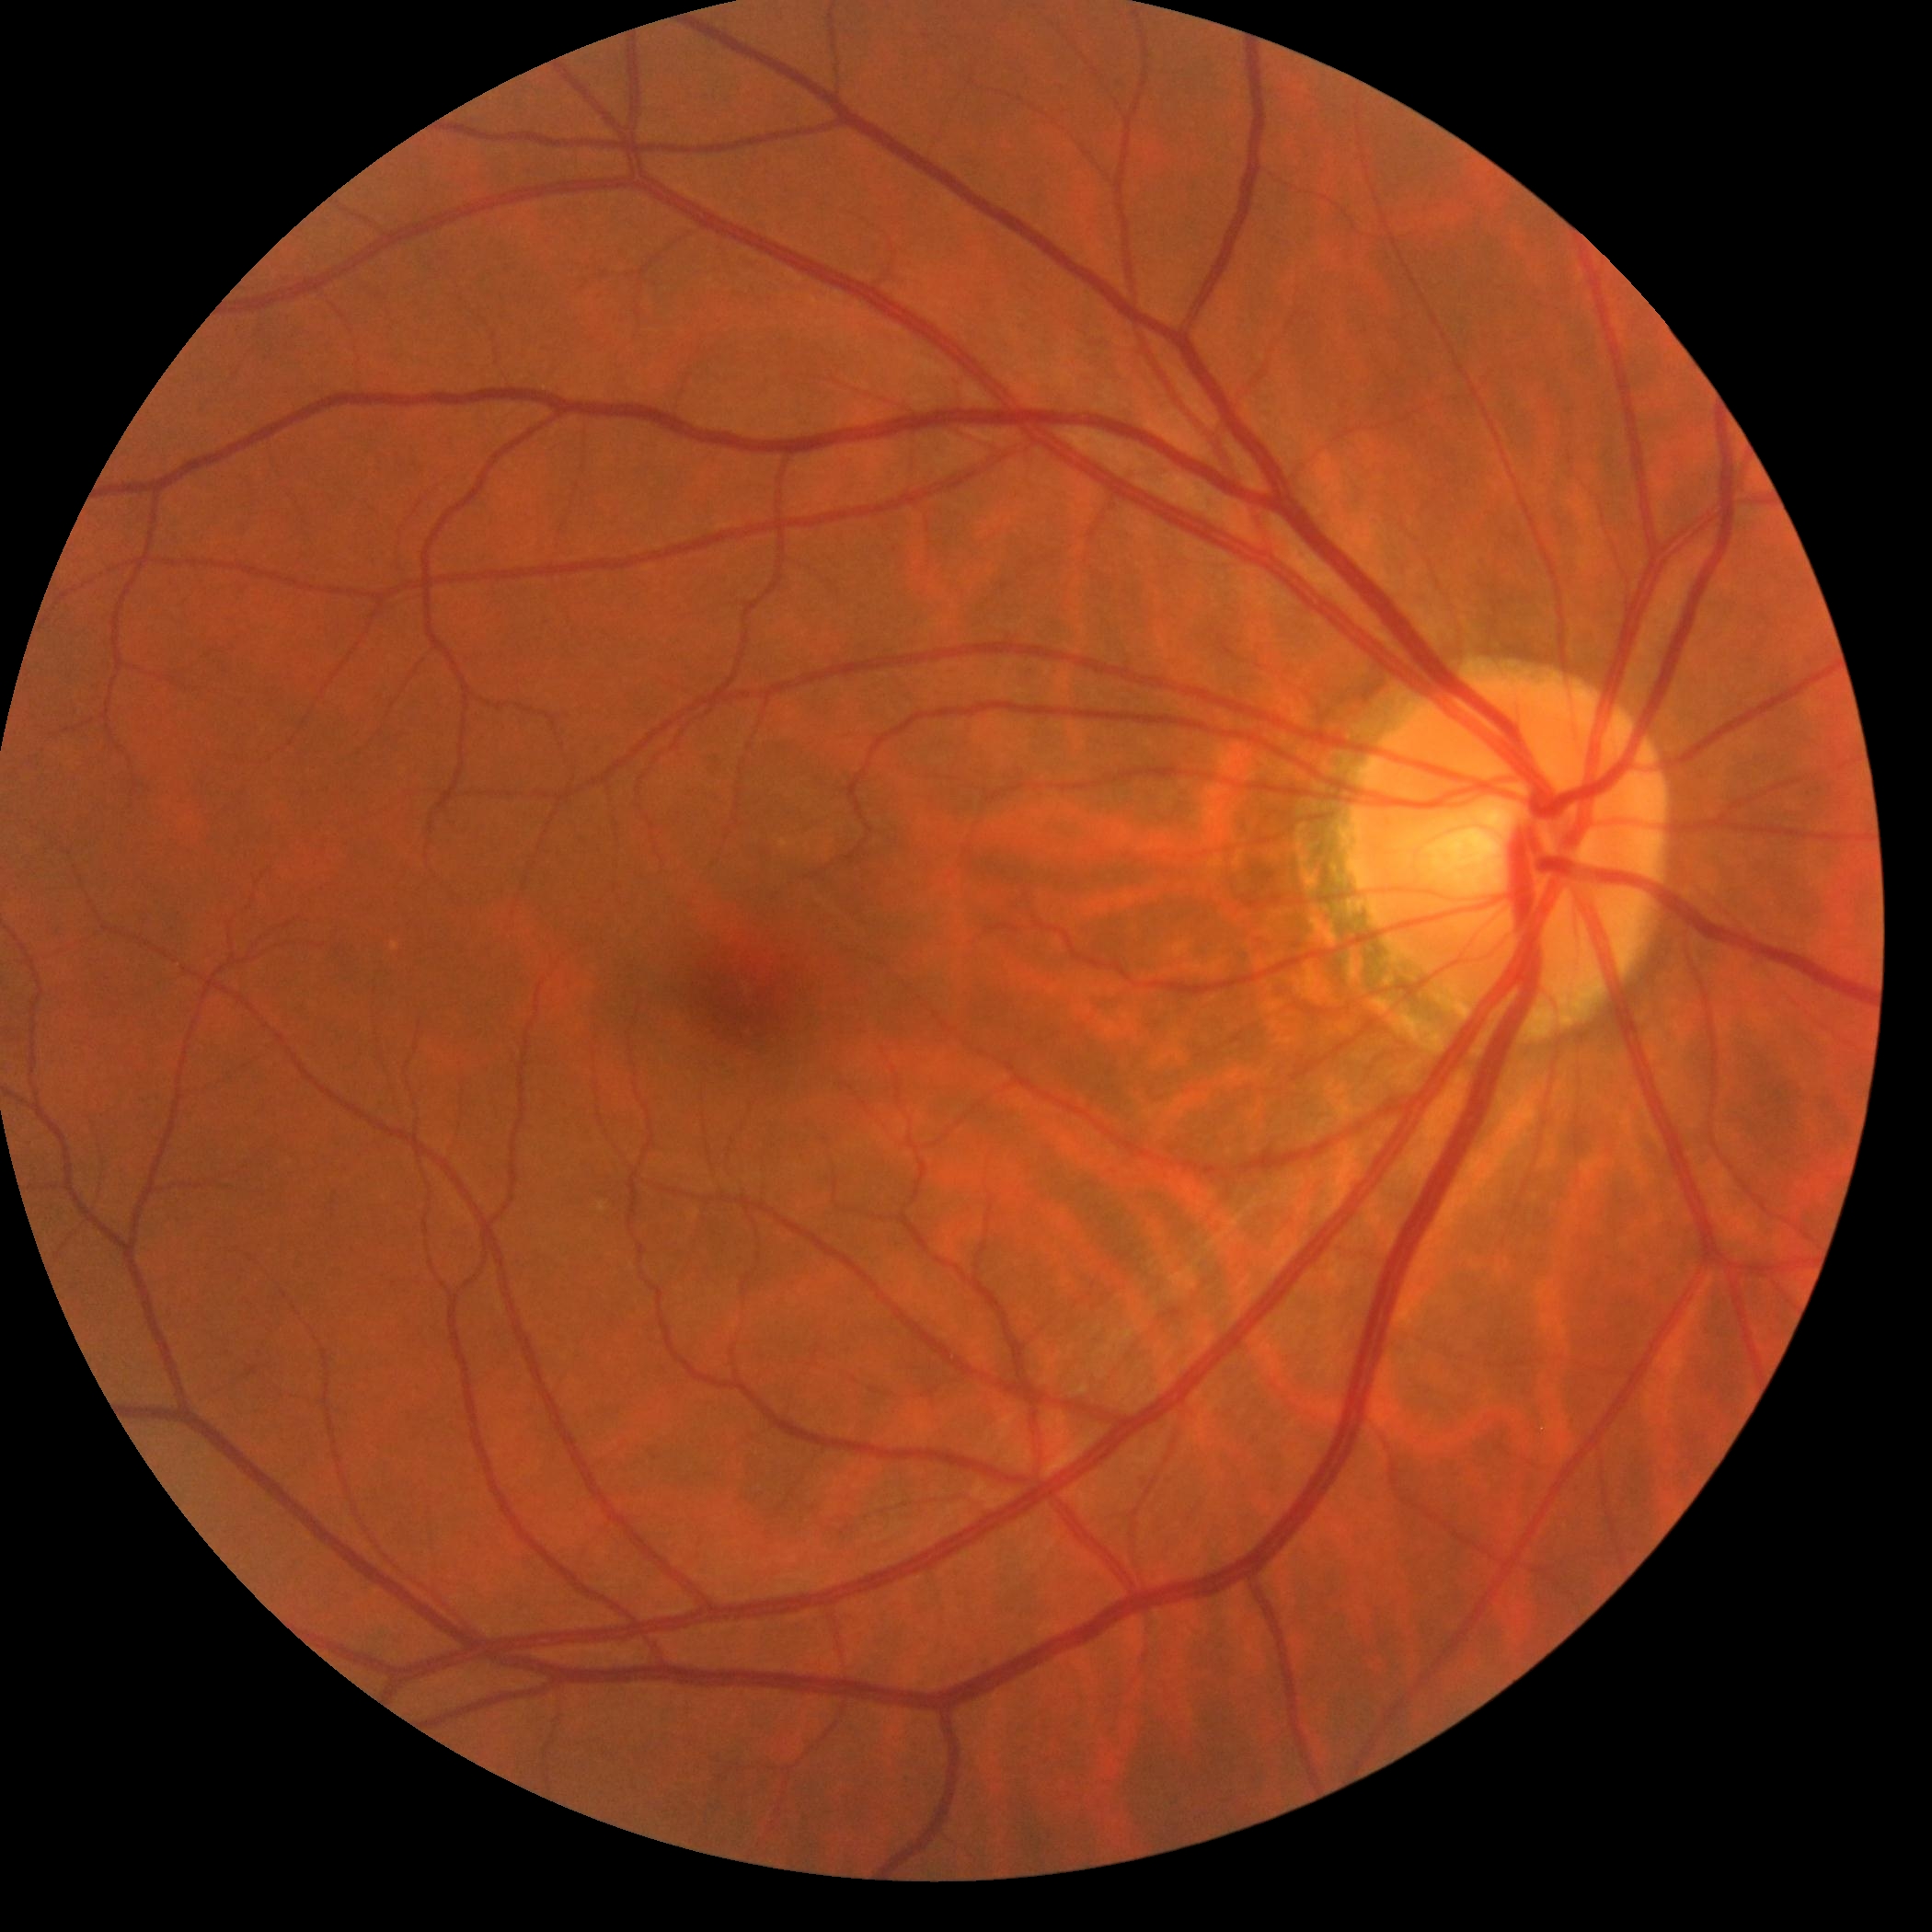 Diabetic retinopathy grade: no apparent retinopathy (0).